2212 x 1659 pixels. Fundus photo. FOV: 45 degrees: 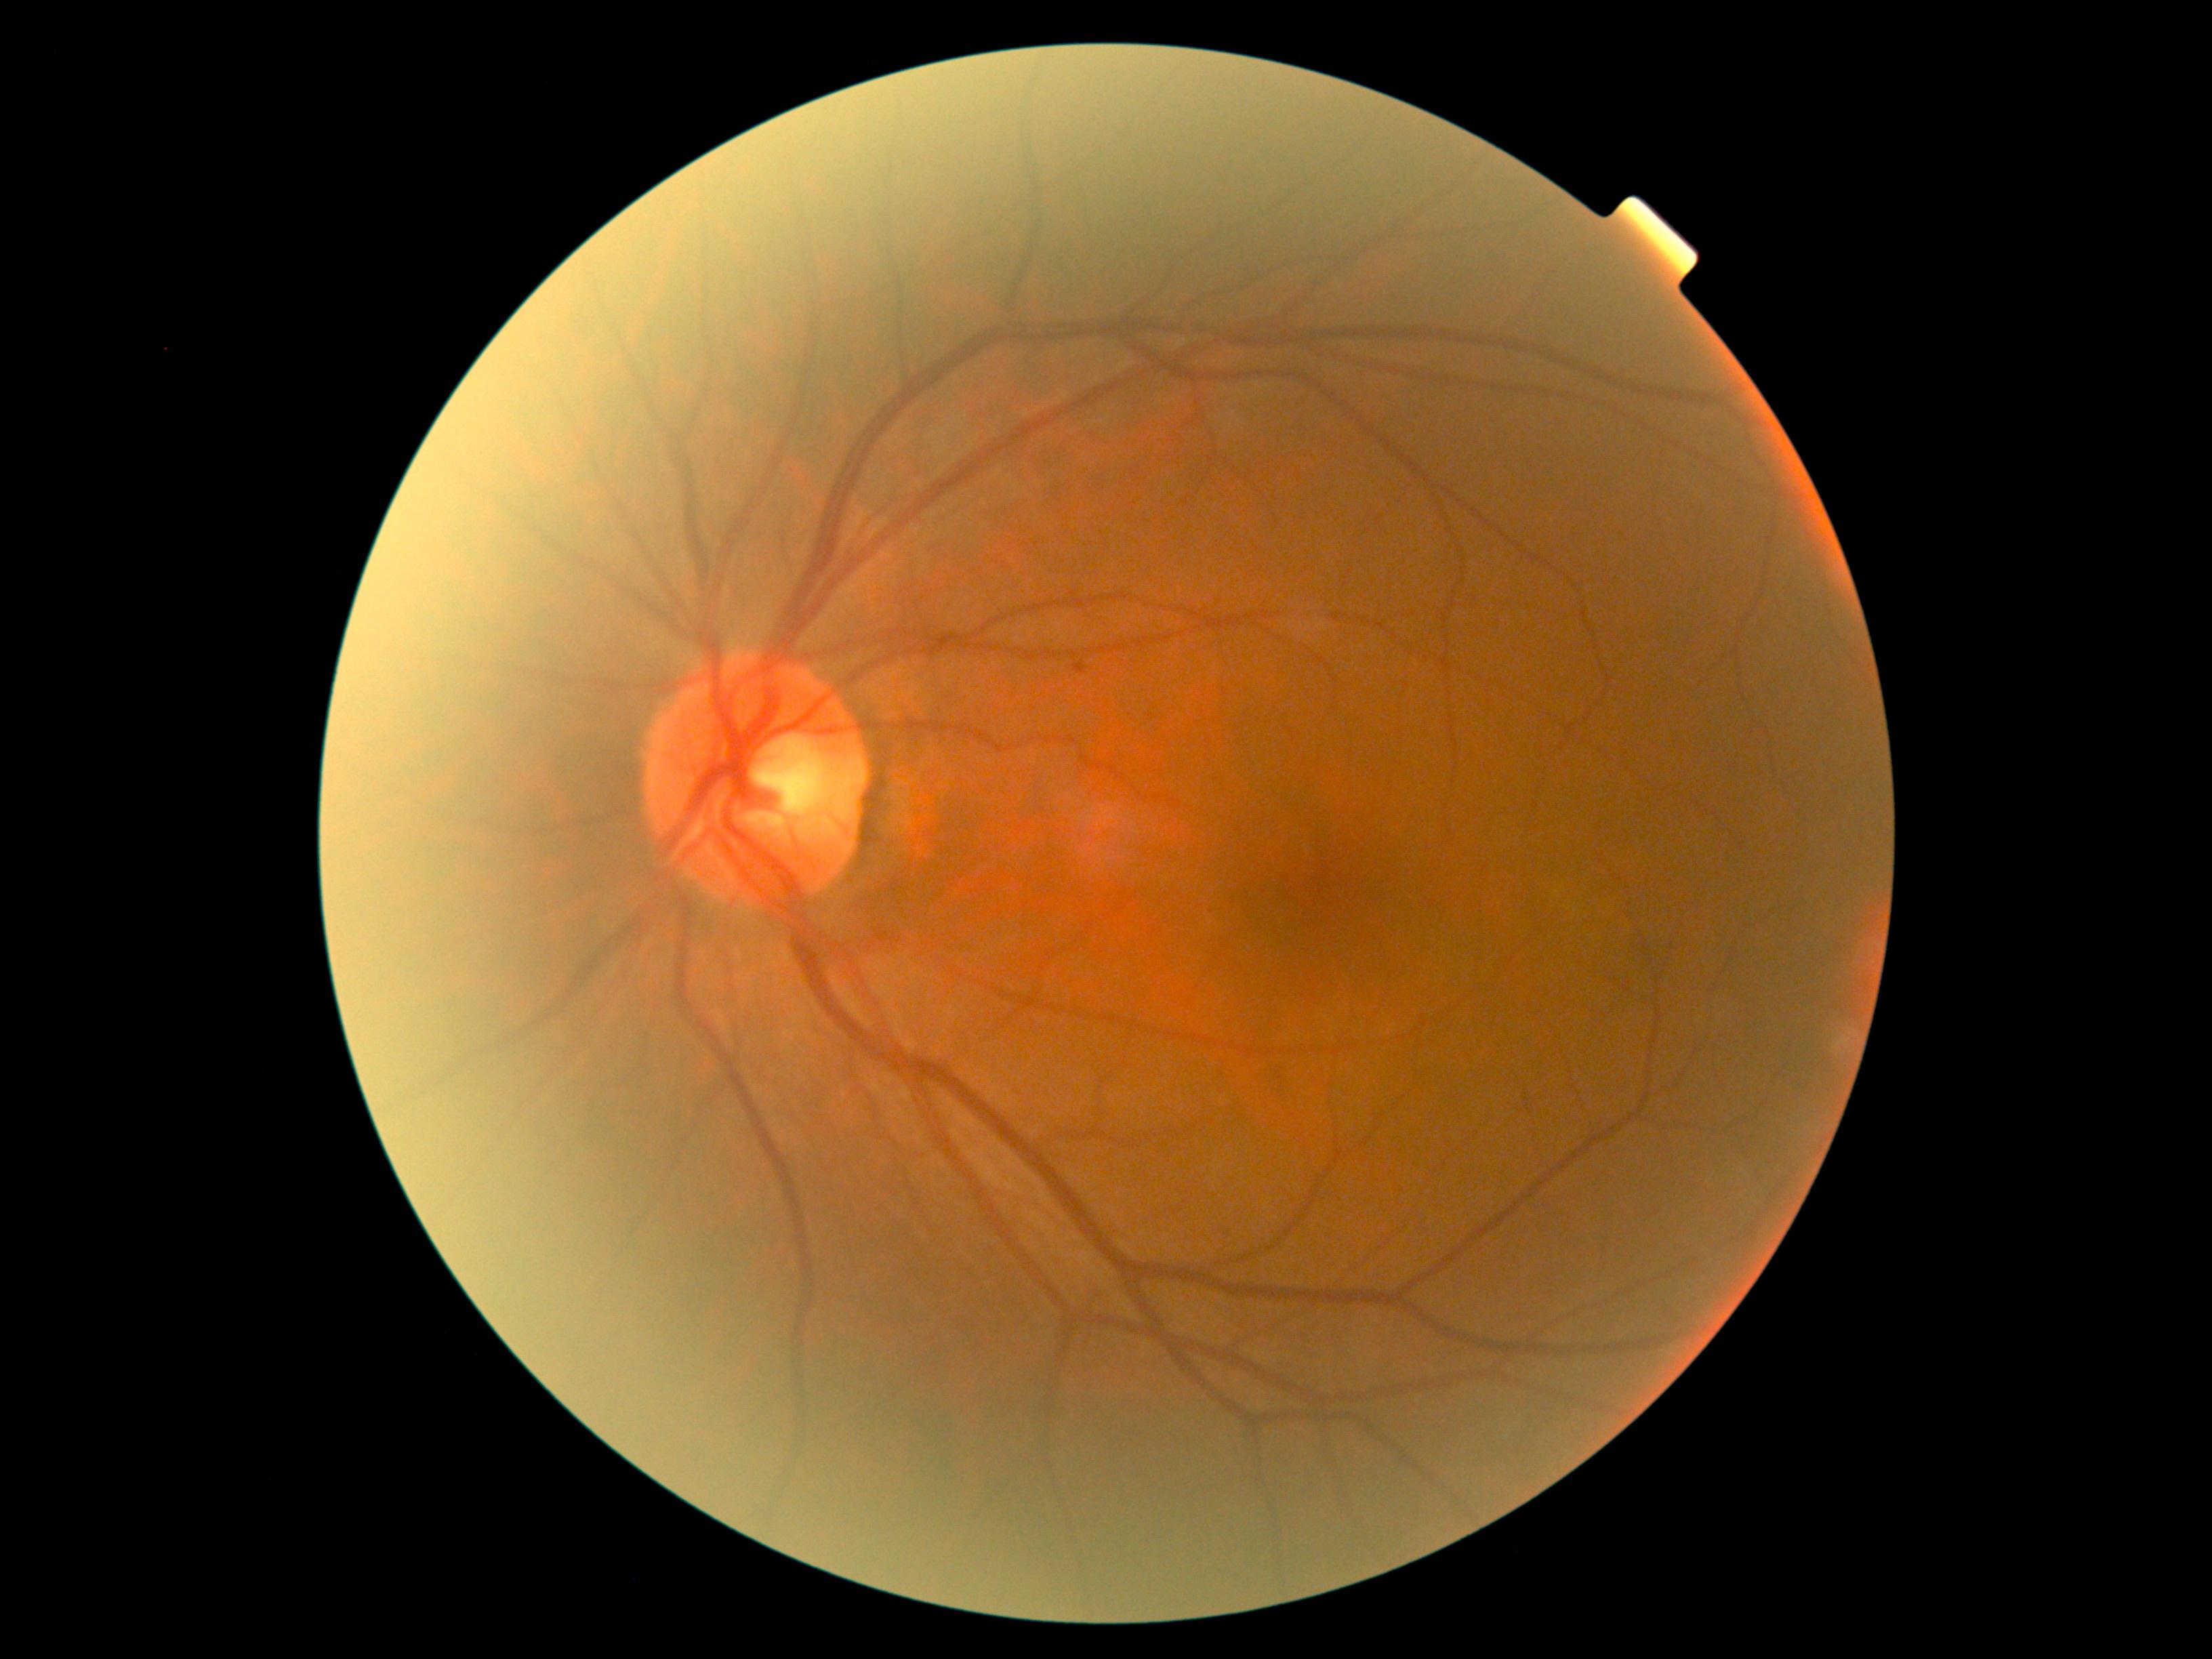
dr_grade: grade 1